848x848, 45-degree field of view, nonmydriatic fundus photograph
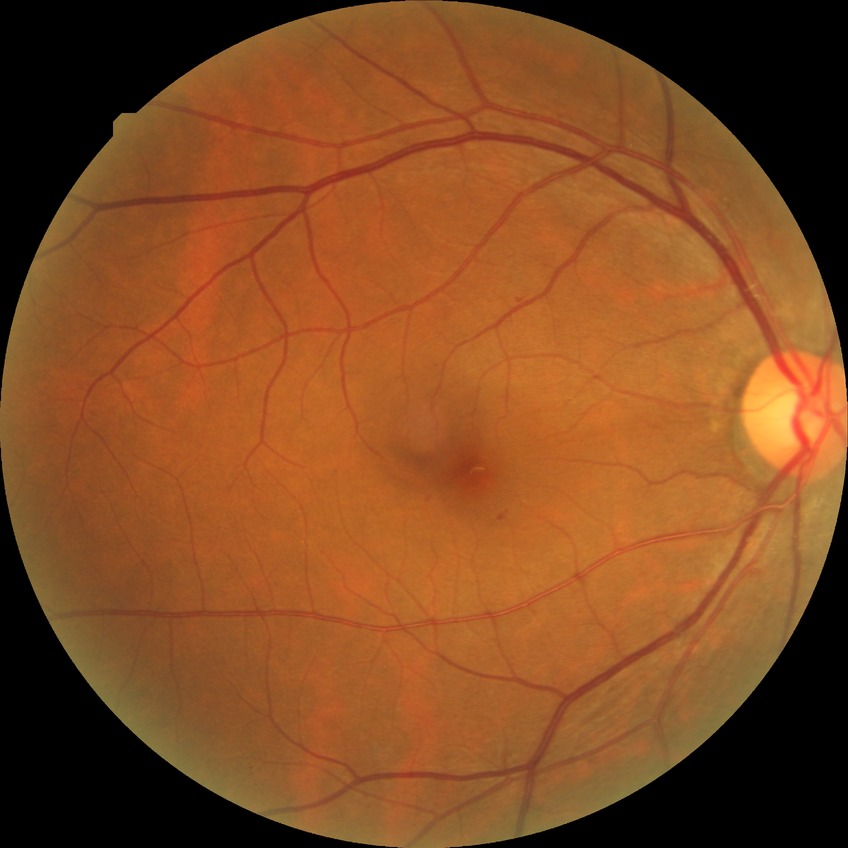
Diabetic retinopathy (DR) is SDR (simple diabetic retinopathy).